Captured with the Phoenix ICON (100° field of view); 1240 by 1240 pixels; wide-field fundus image from infant ROP screening — 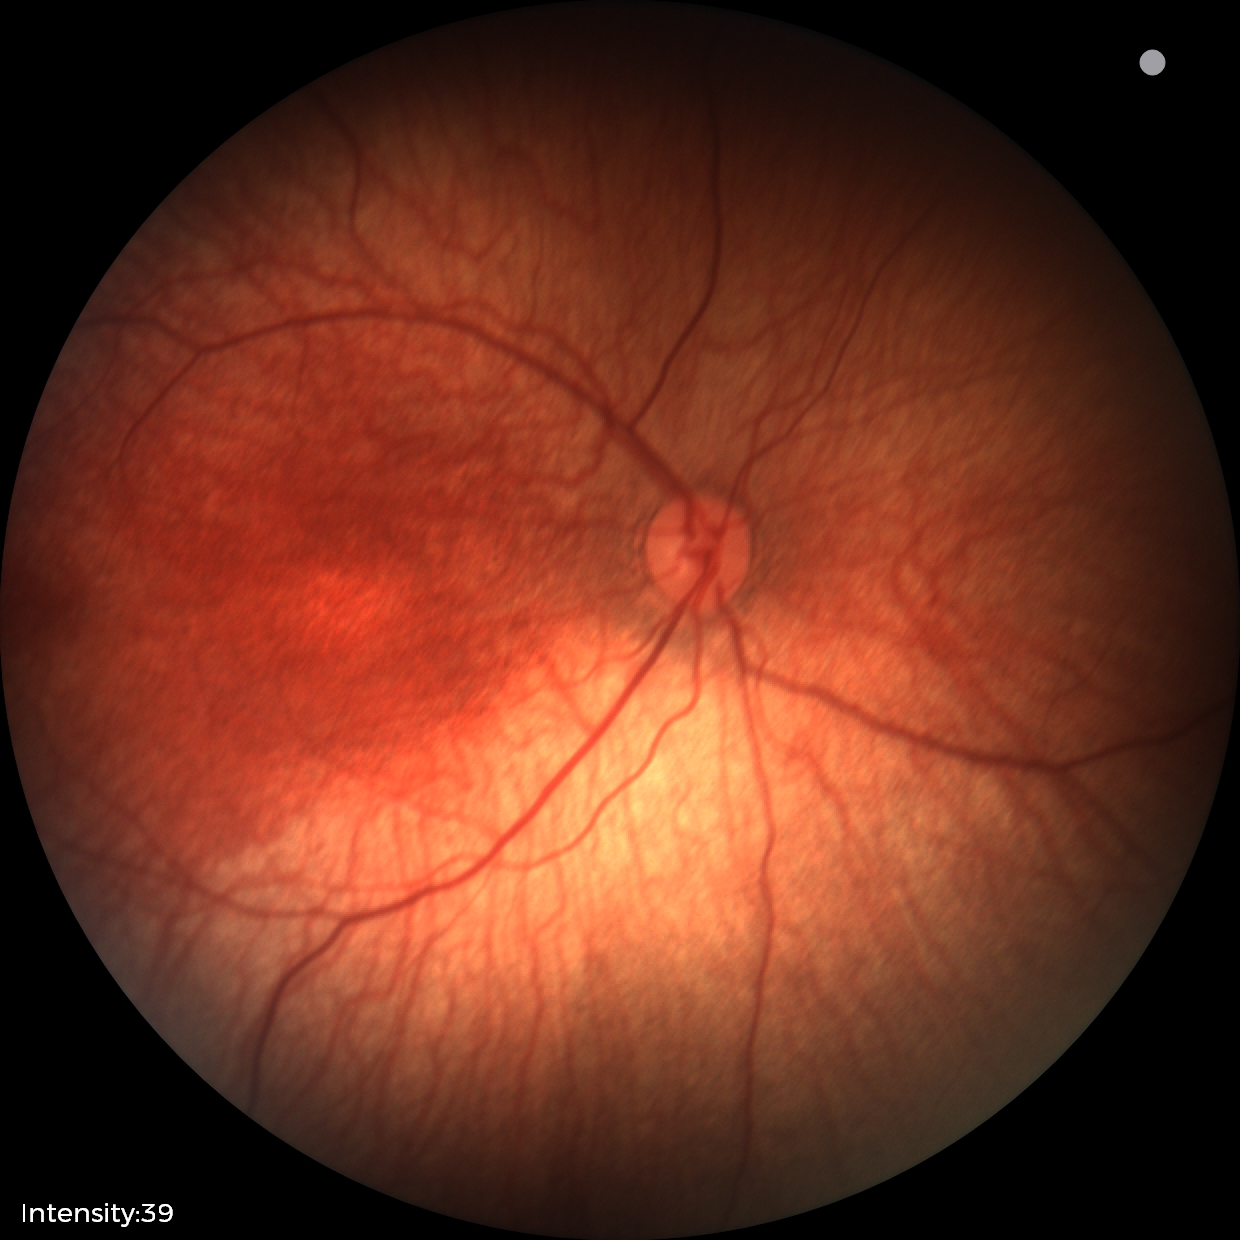 Screening examination with no abnormal retinal findings.